Infant wide-field retinal image; captured with the Phoenix ICON (100° field of view): 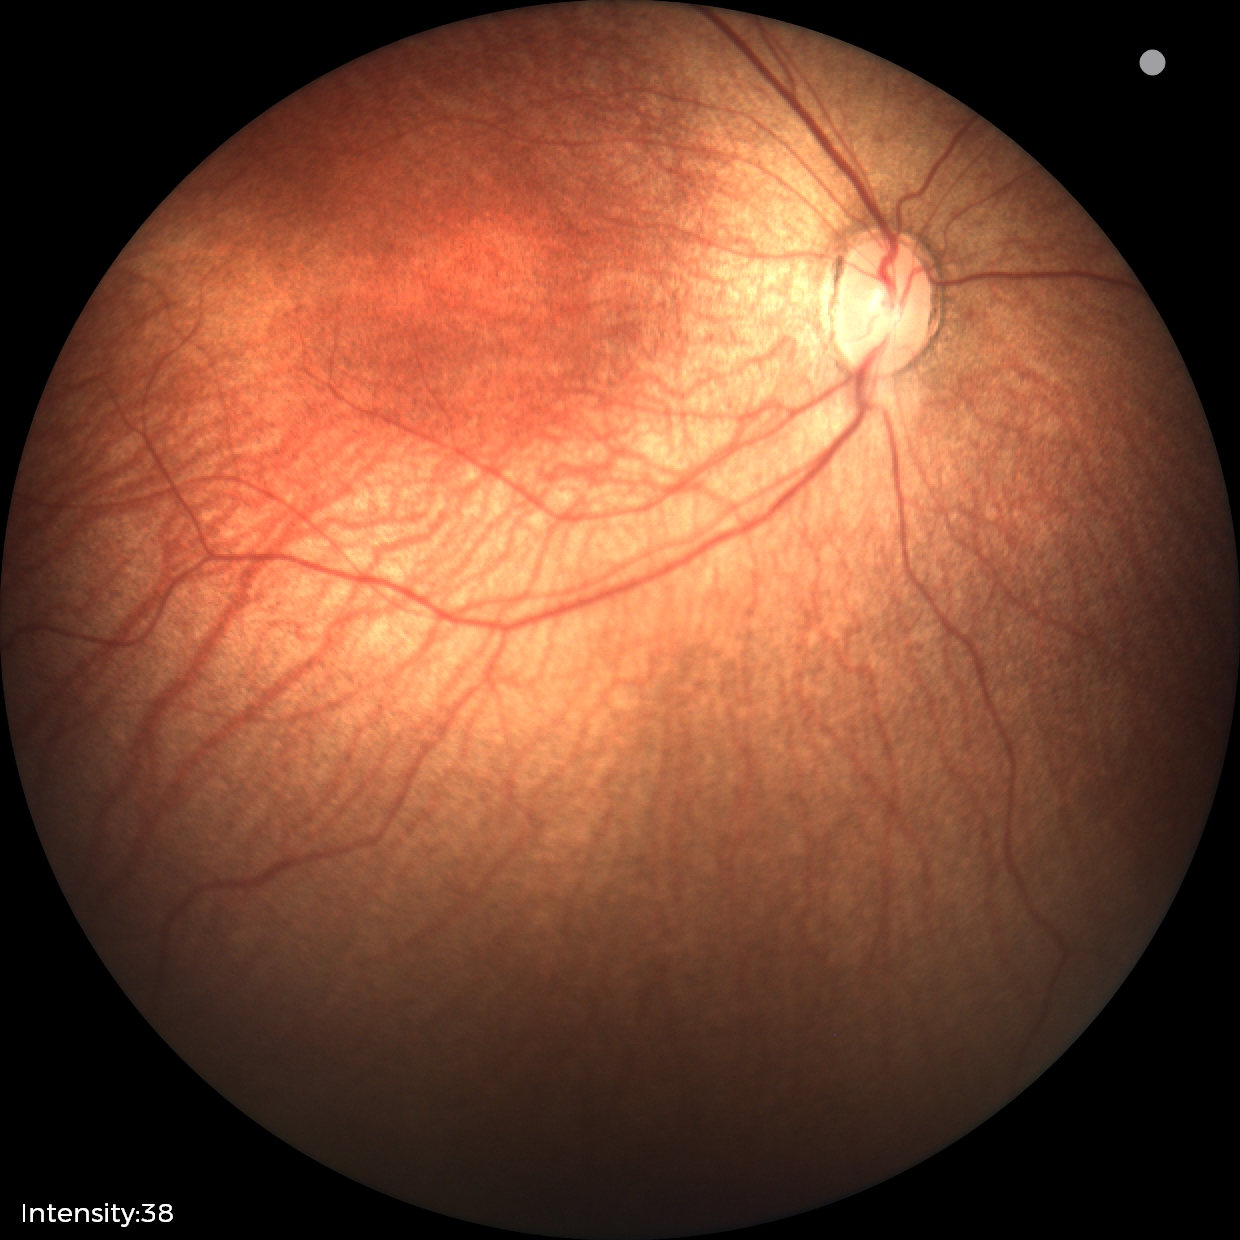
Finding: status post ROP | plus form: absent.